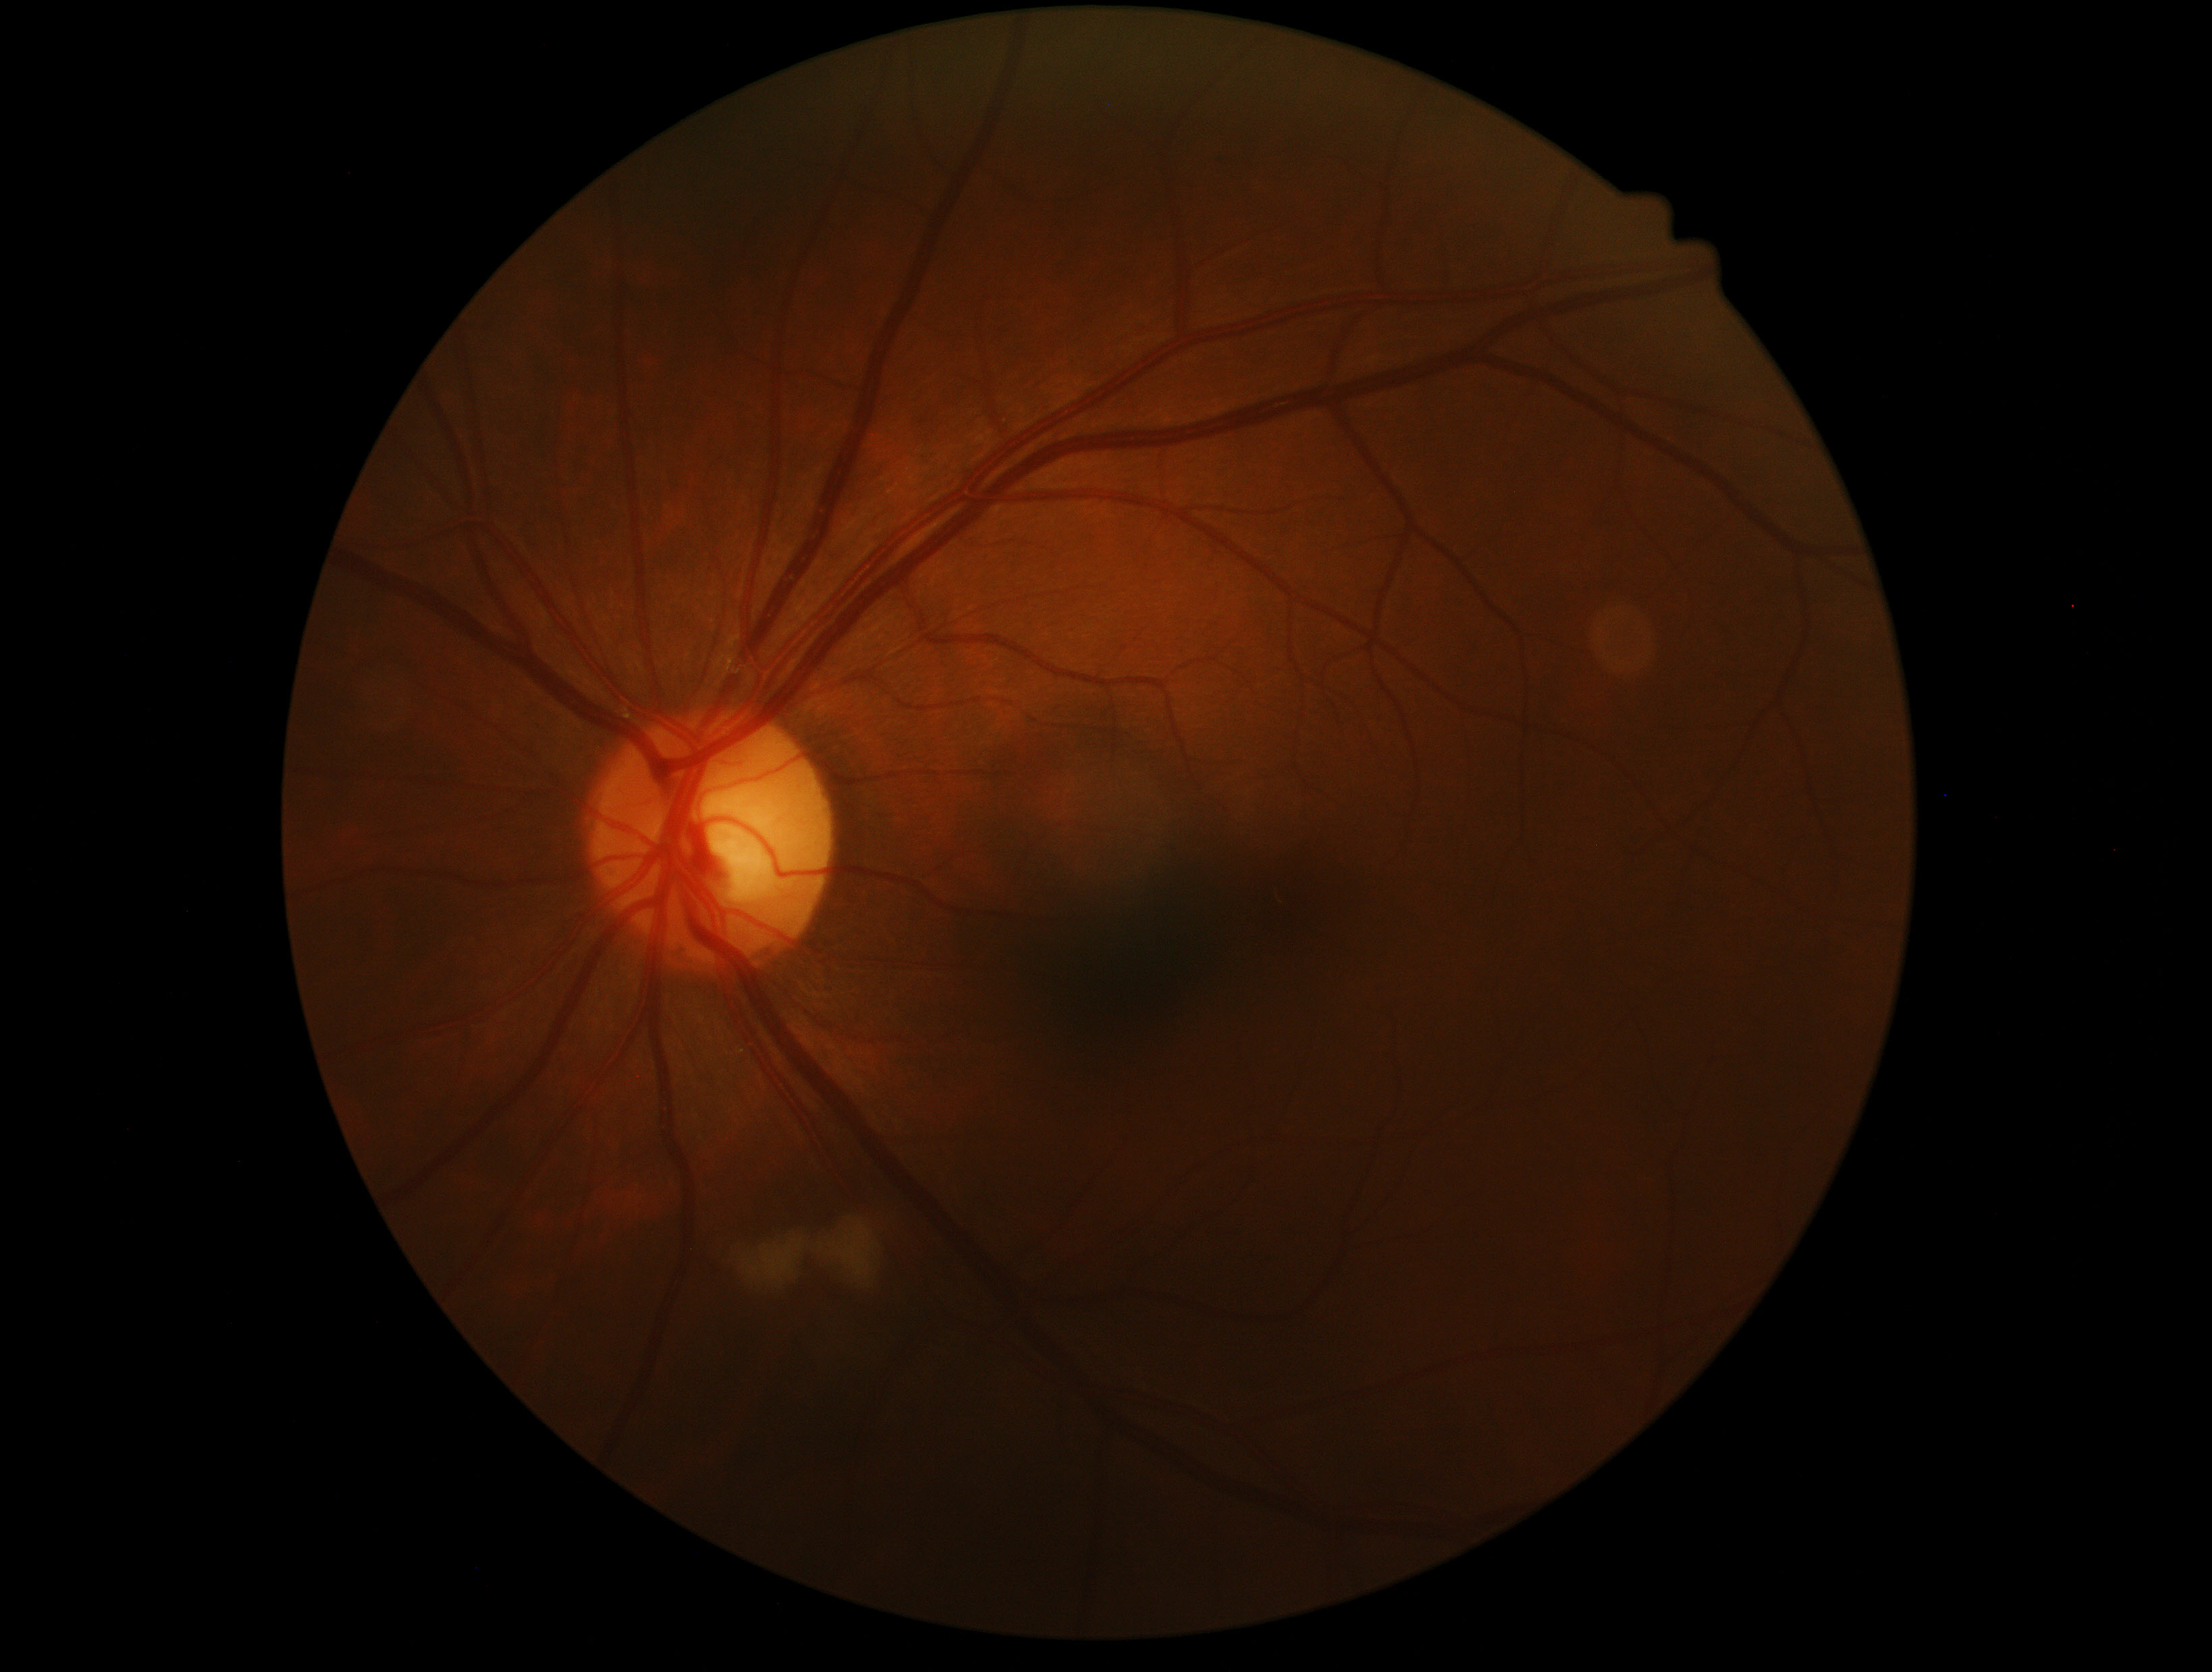 Diabetic retinopathy (DR) is grade 2 (moderate NPDR).